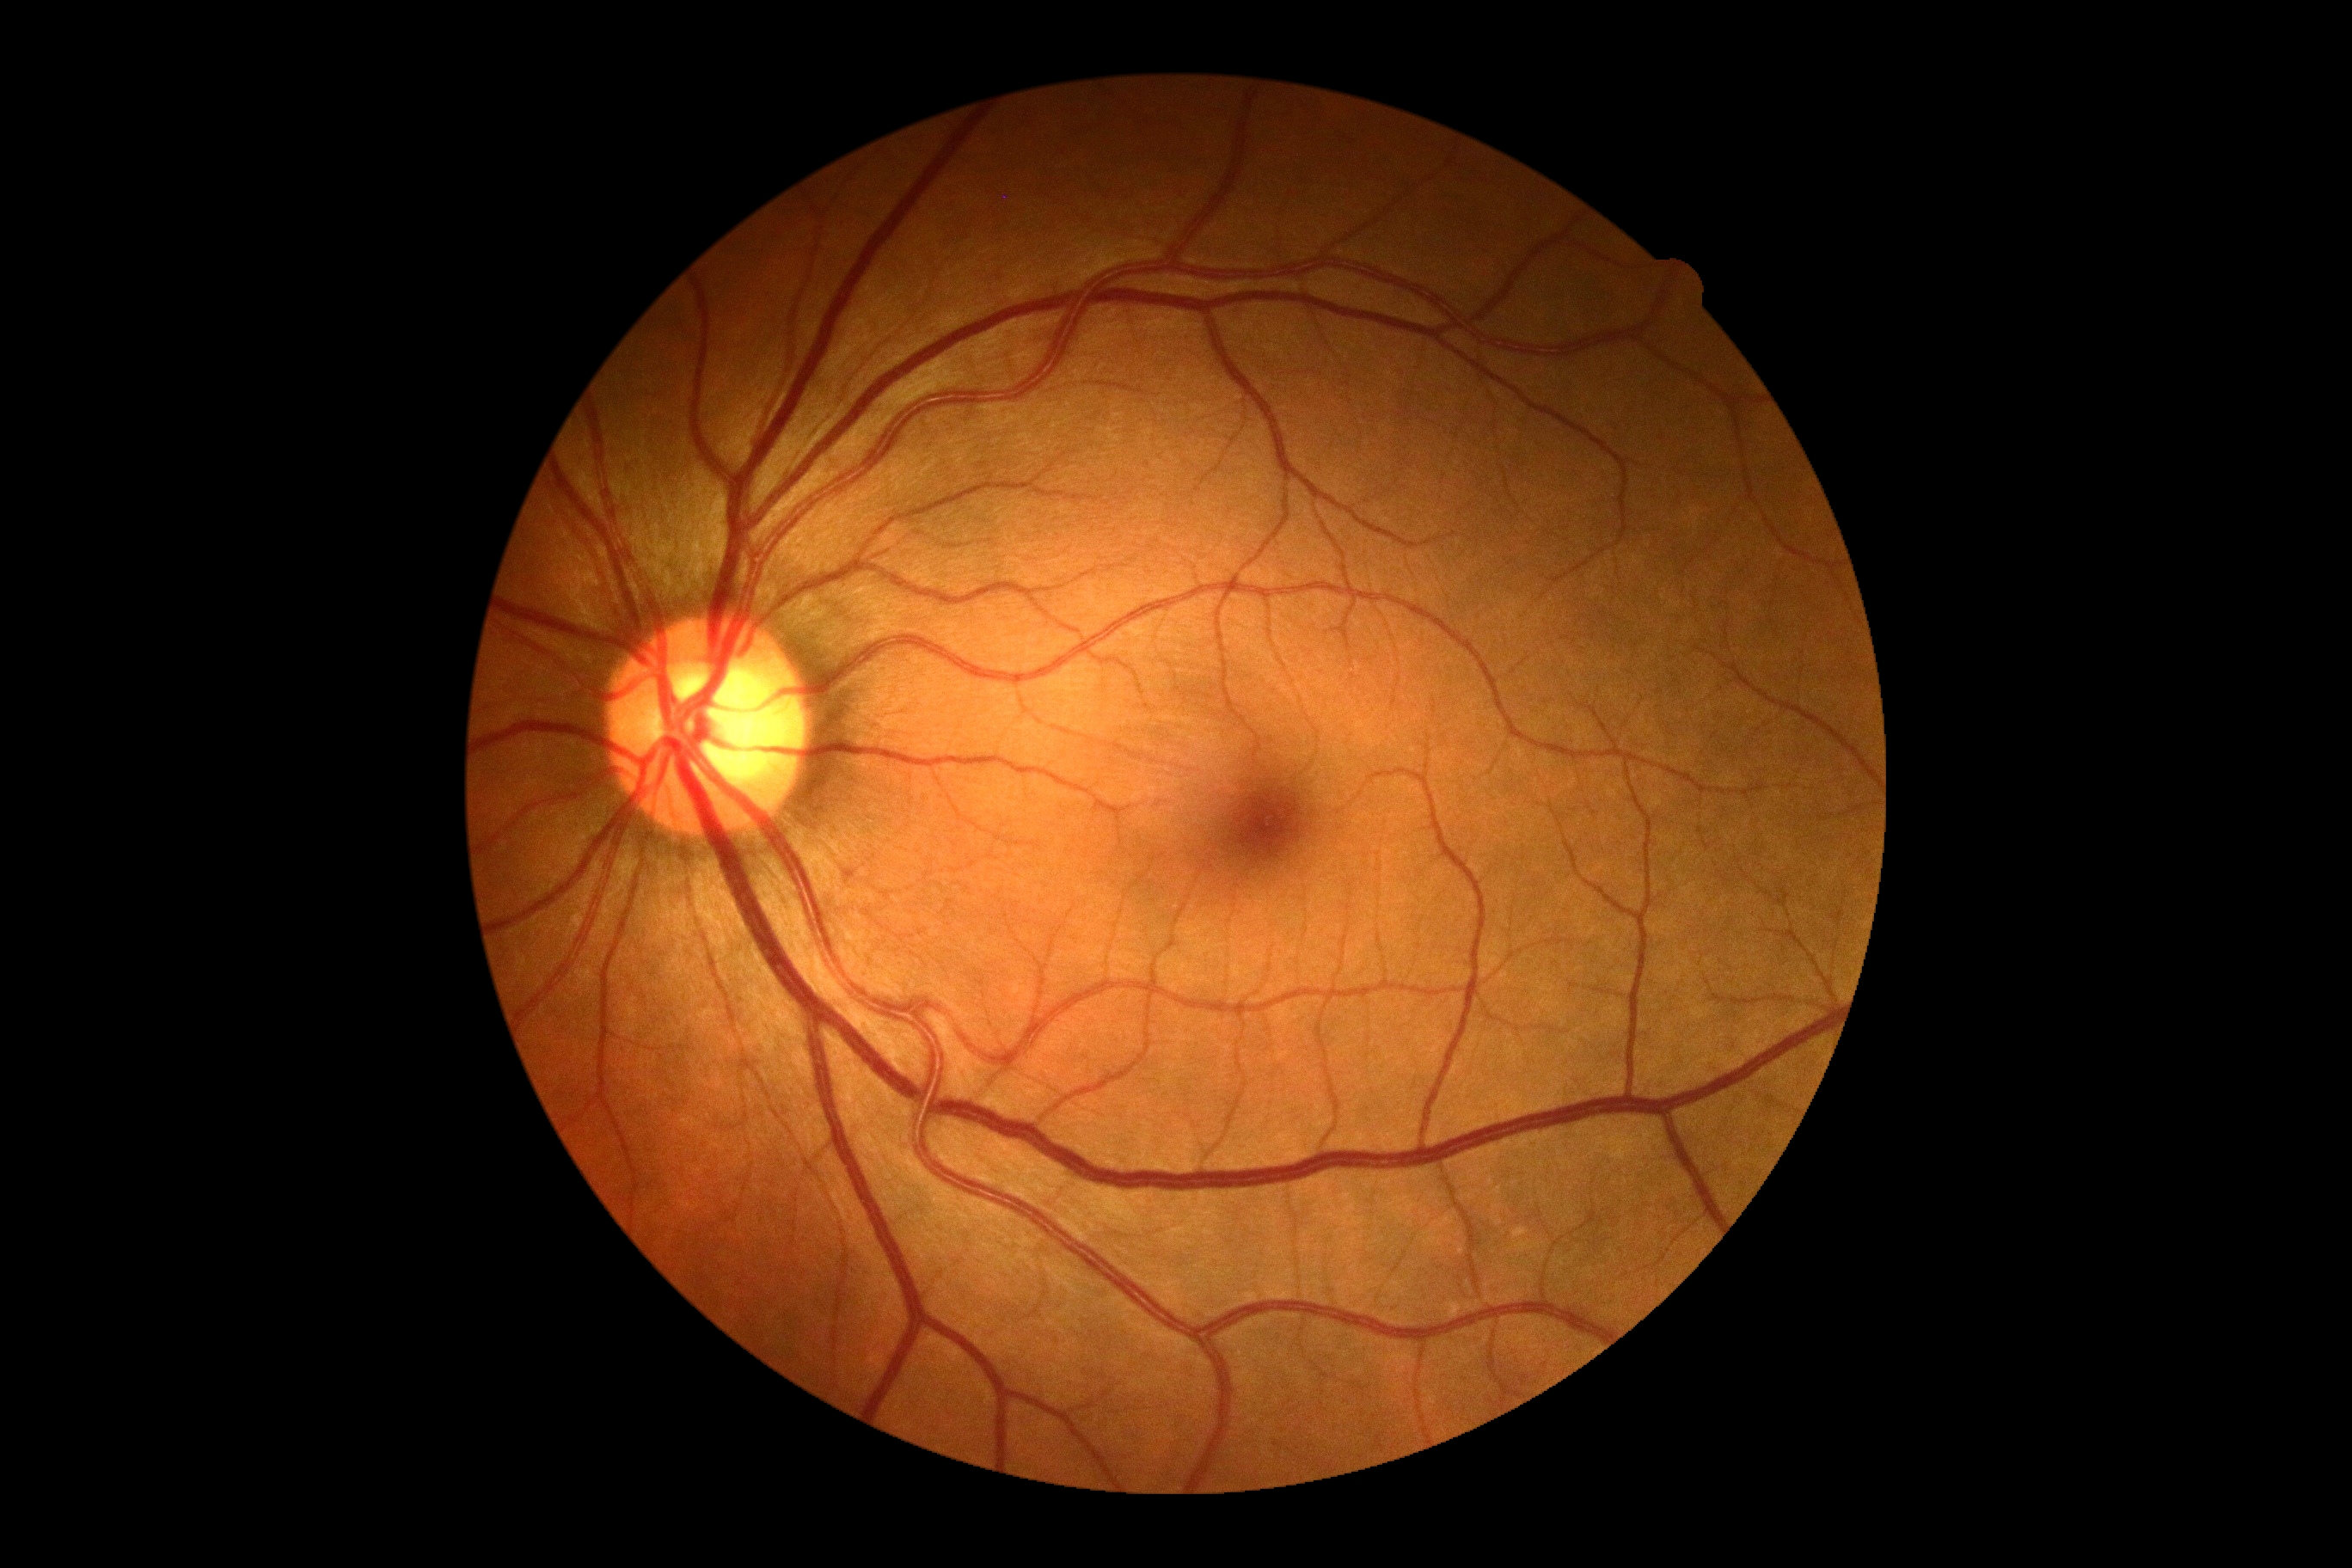

DR severity: grade 0.